Wide-field fundus image from infant ROP screening:
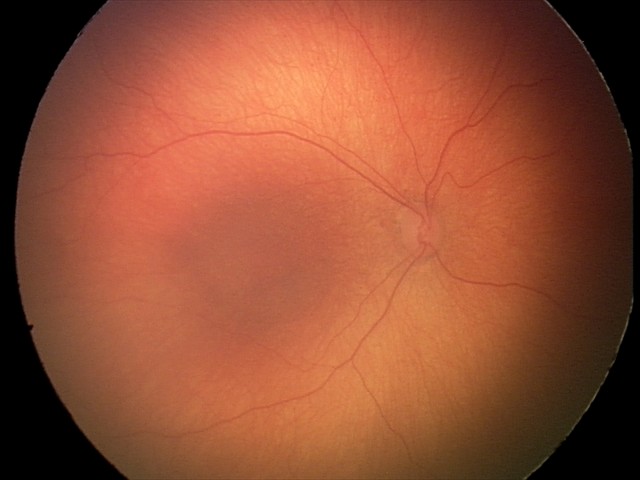
Diagnosis from this screening exam: retinopathy of prematurity stage 1.
Without plus disease.